Fundus photo — 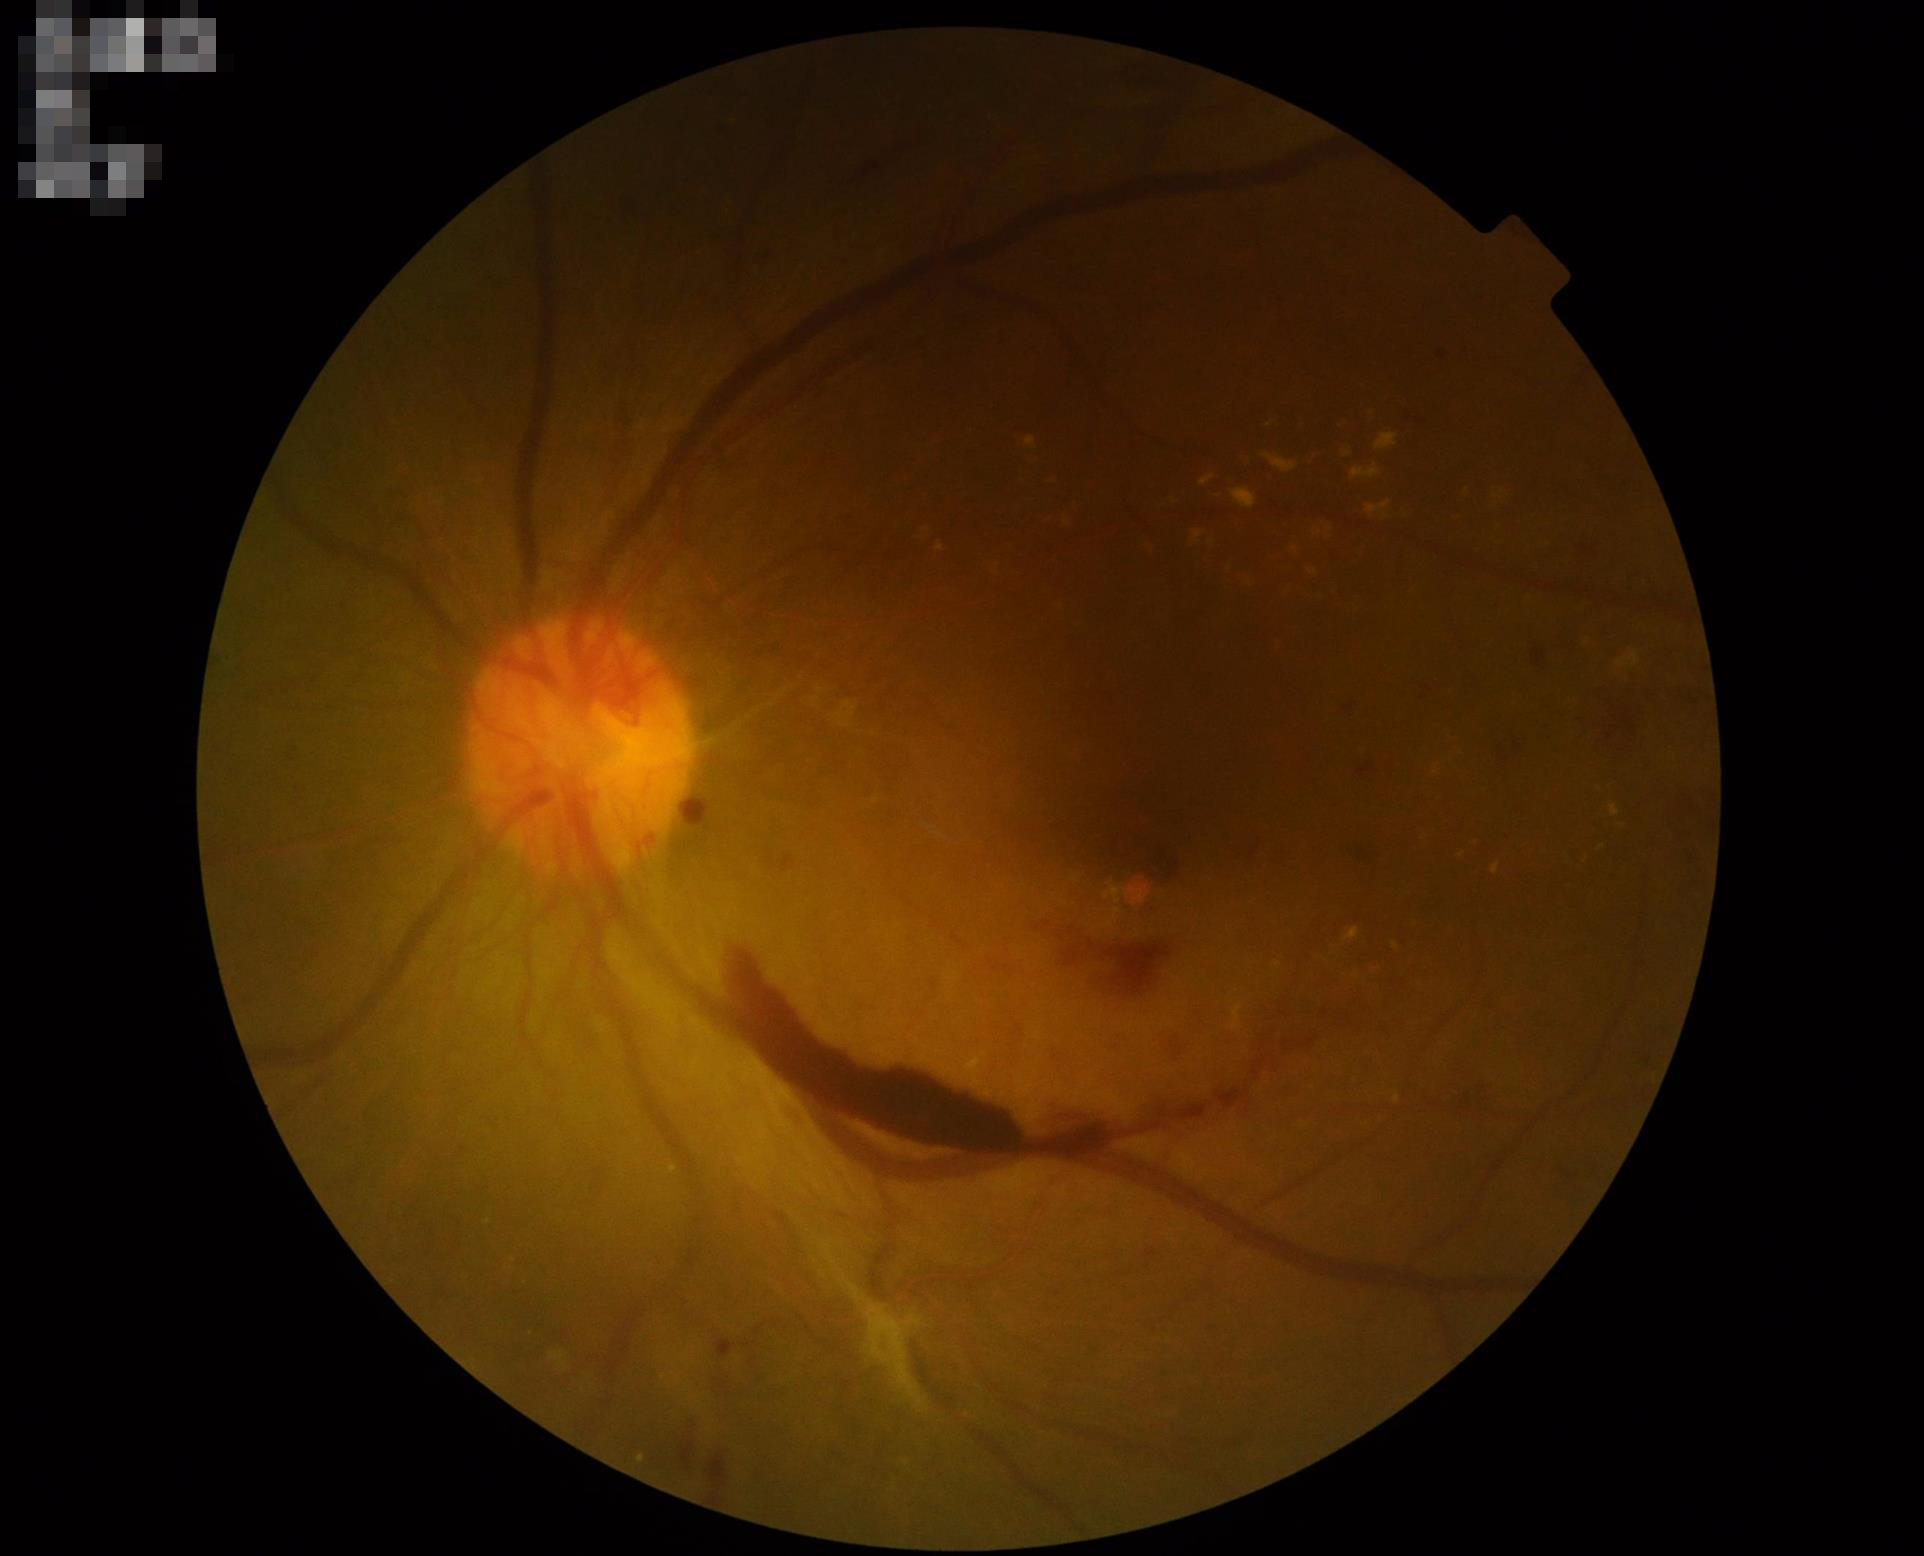
  contrast: adequate
  clarity: in focus
  overall_quality: acceptable
  illumination: uneven